Retinal fundus photograph. FOV: 45 degrees. Image size 2352x1568: 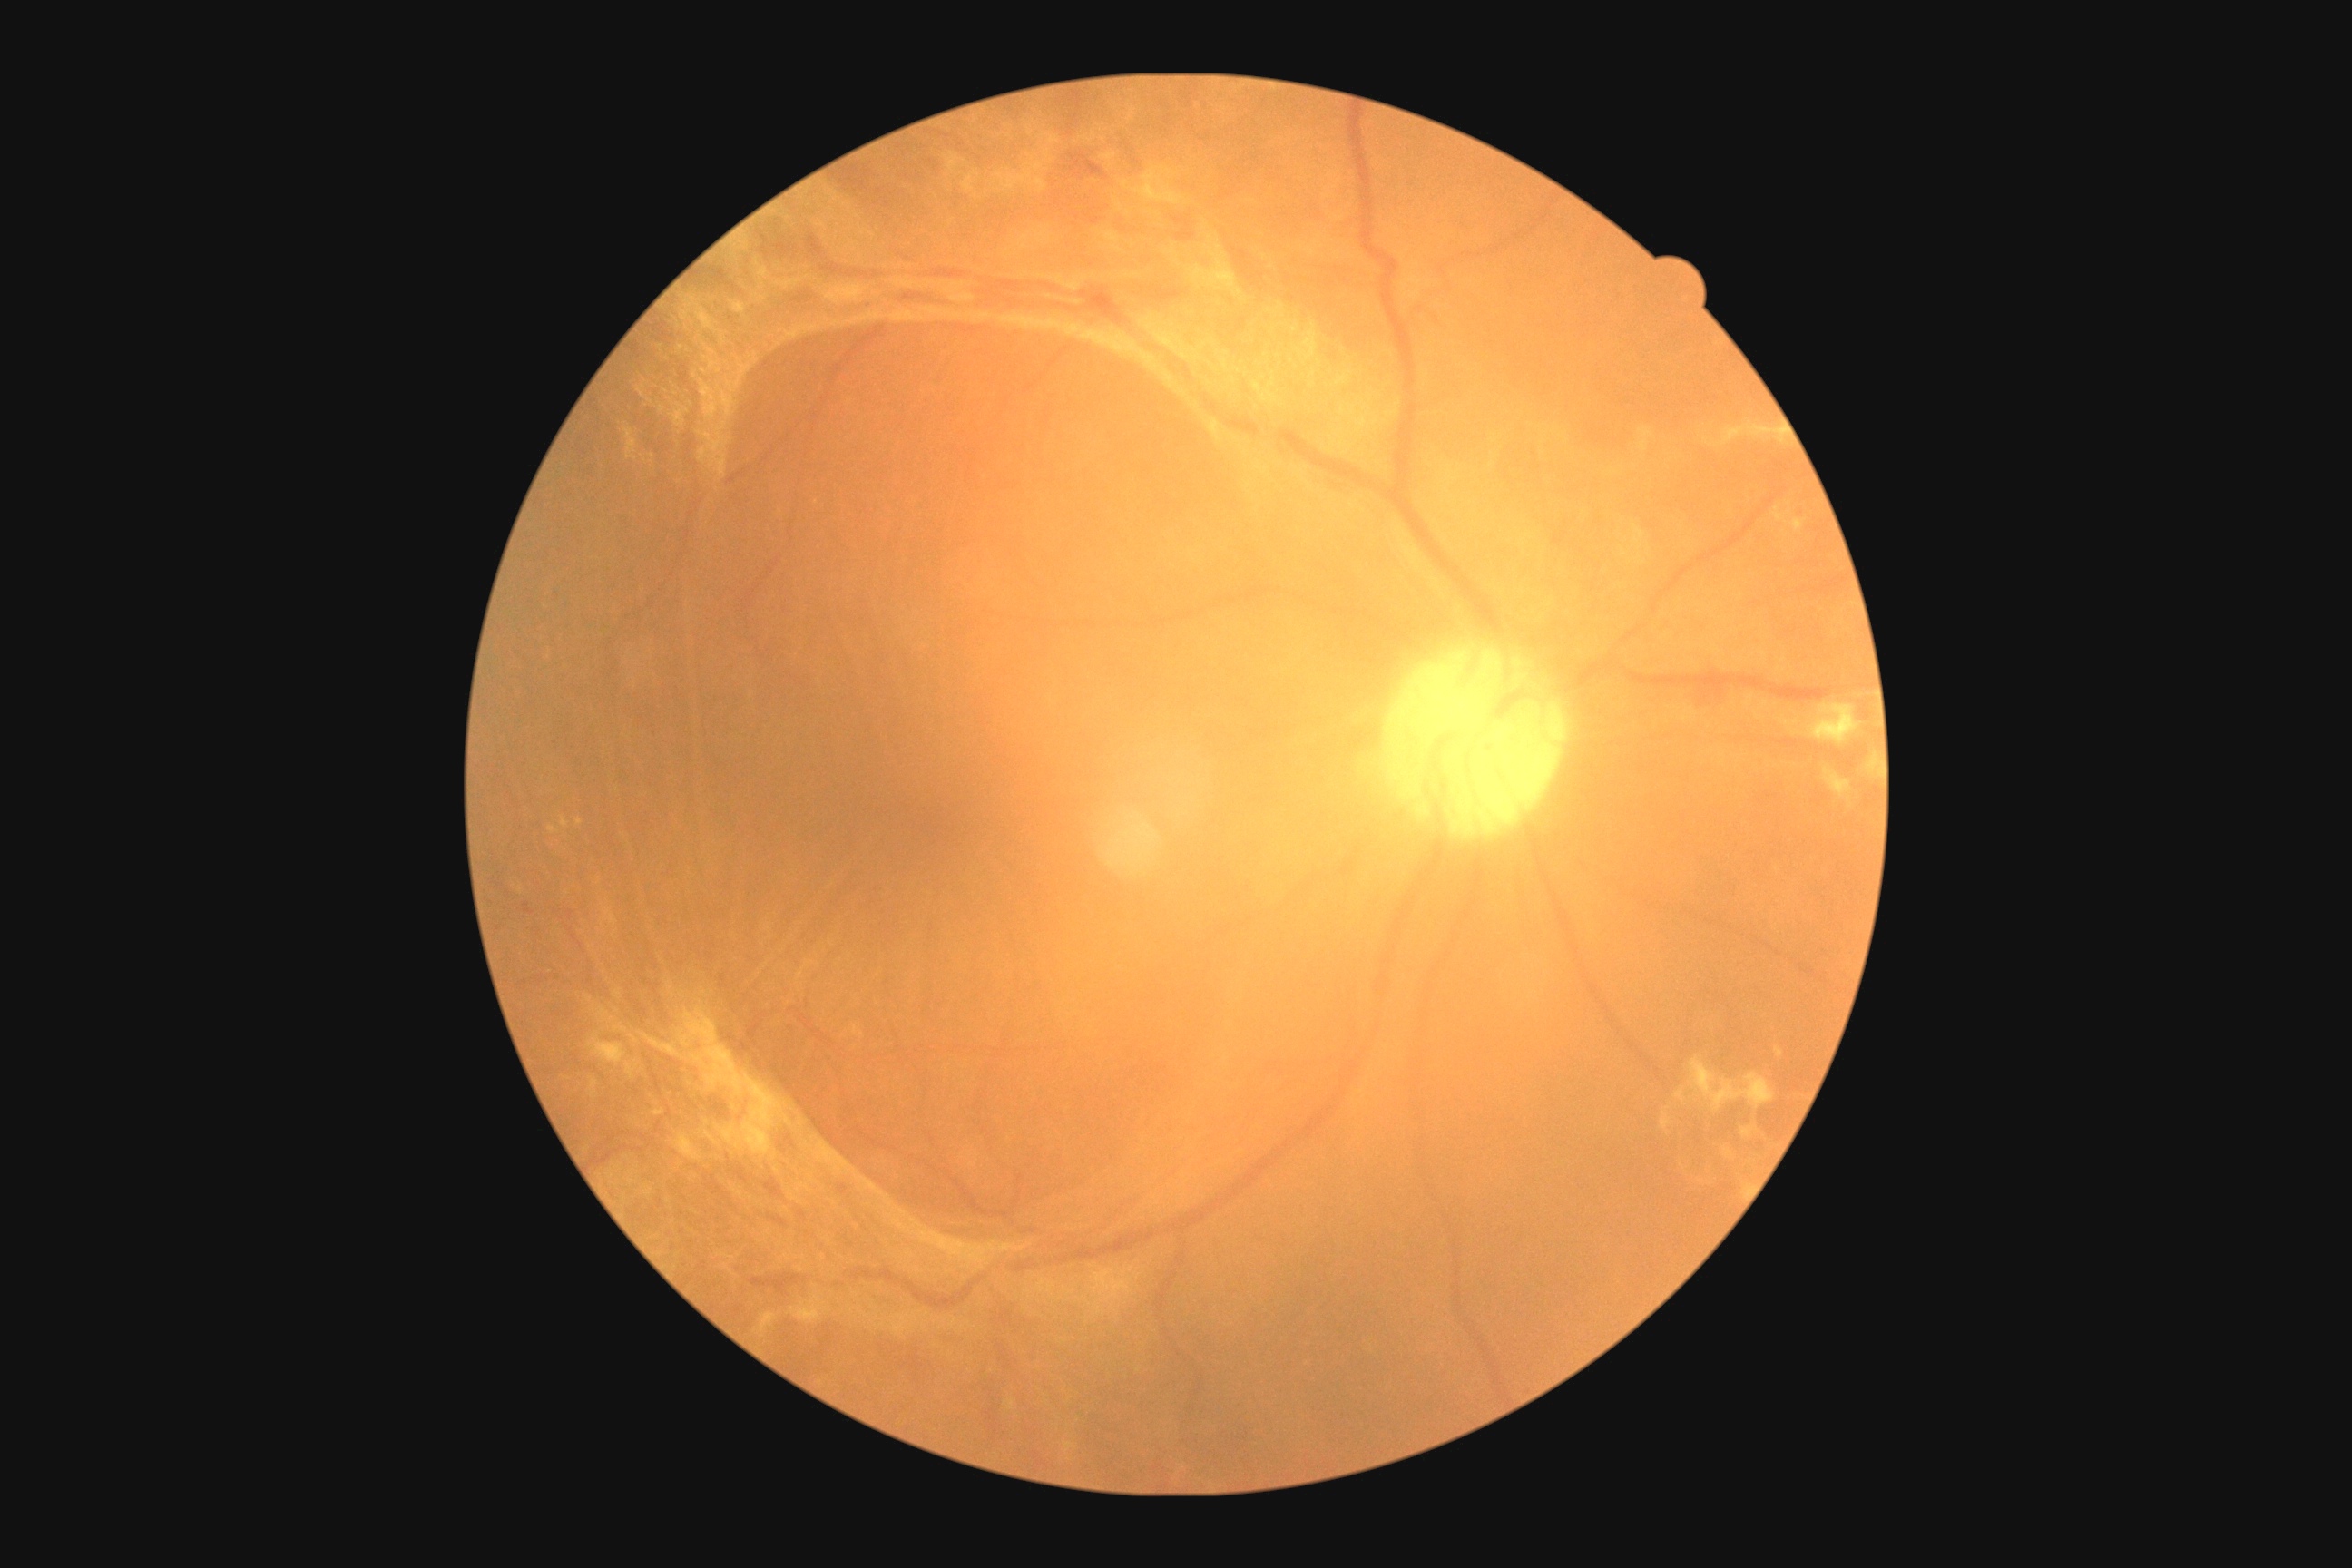
Diabetic retinopathy (DR) is proliferative diabetic retinopathy (grade 4).